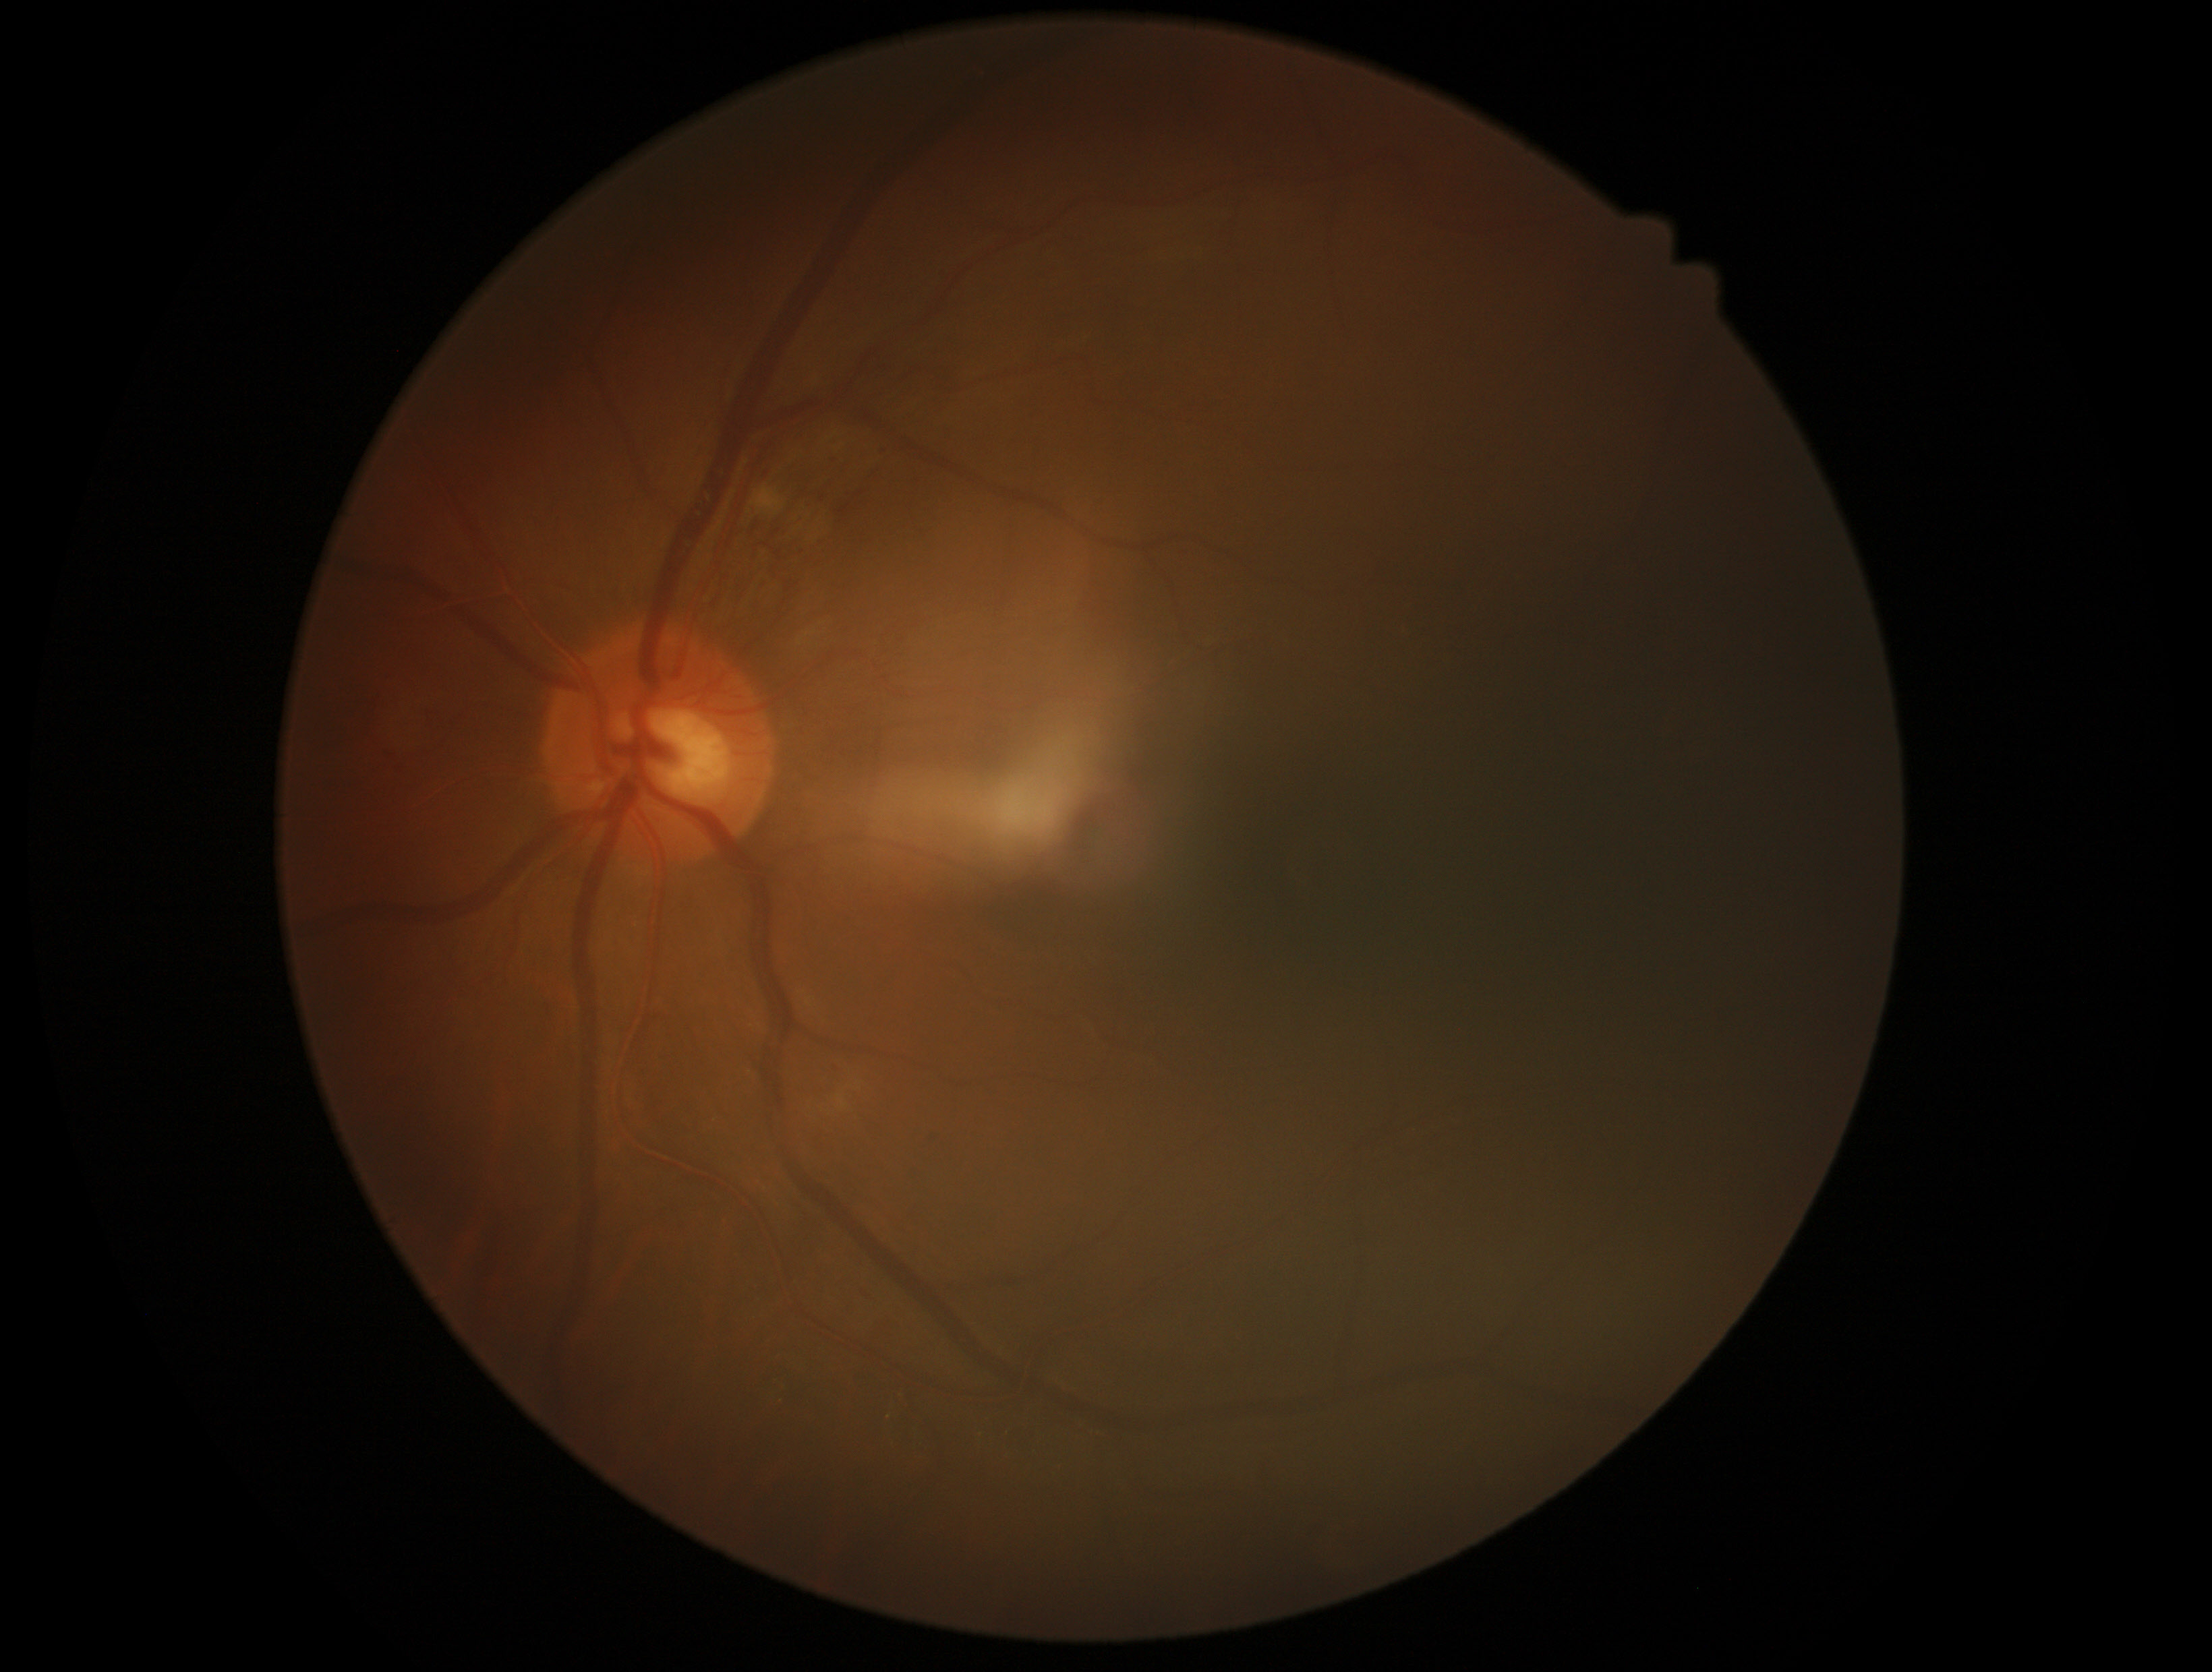

Retinopathy grade: moderate non-proliferative diabetic retinopathy (2). Disease class: non-proliferative diabetic retinopathy.